45-degree field of view · color fundus image · NIDEK AFC-230 fundus camera · 848 x 848 pixels.
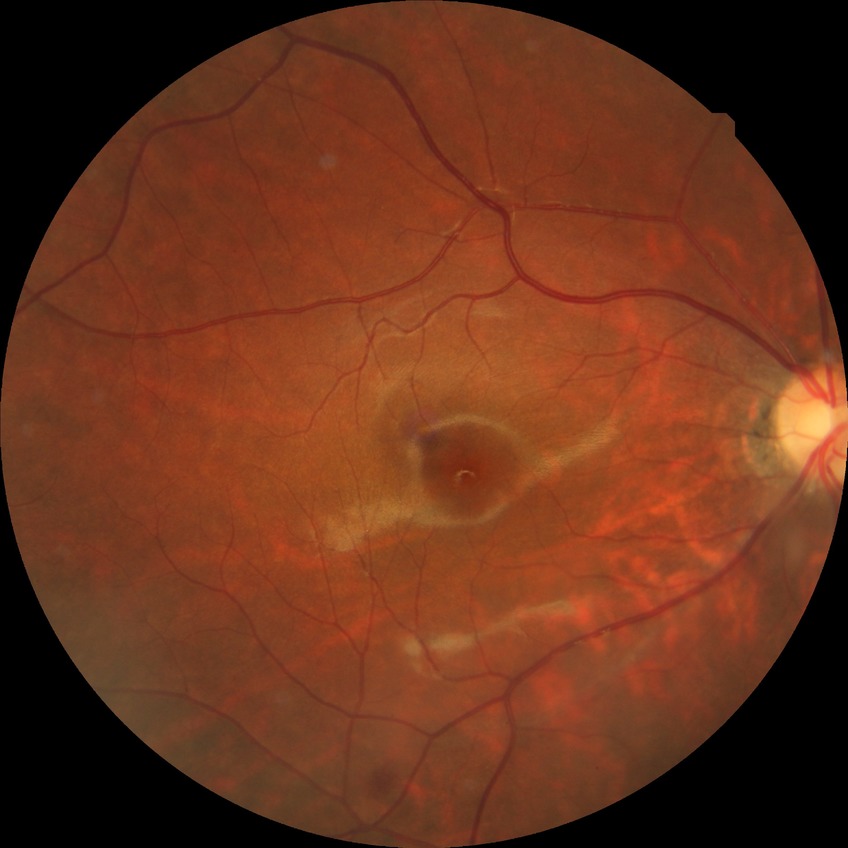
Diabetic retinopathy severity is simple diabetic retinopathy.